Phoenix ICON wide-field infant fundus image · 1240 x 1240 pixels · captured with the Phoenix ICON (100° field of view) — 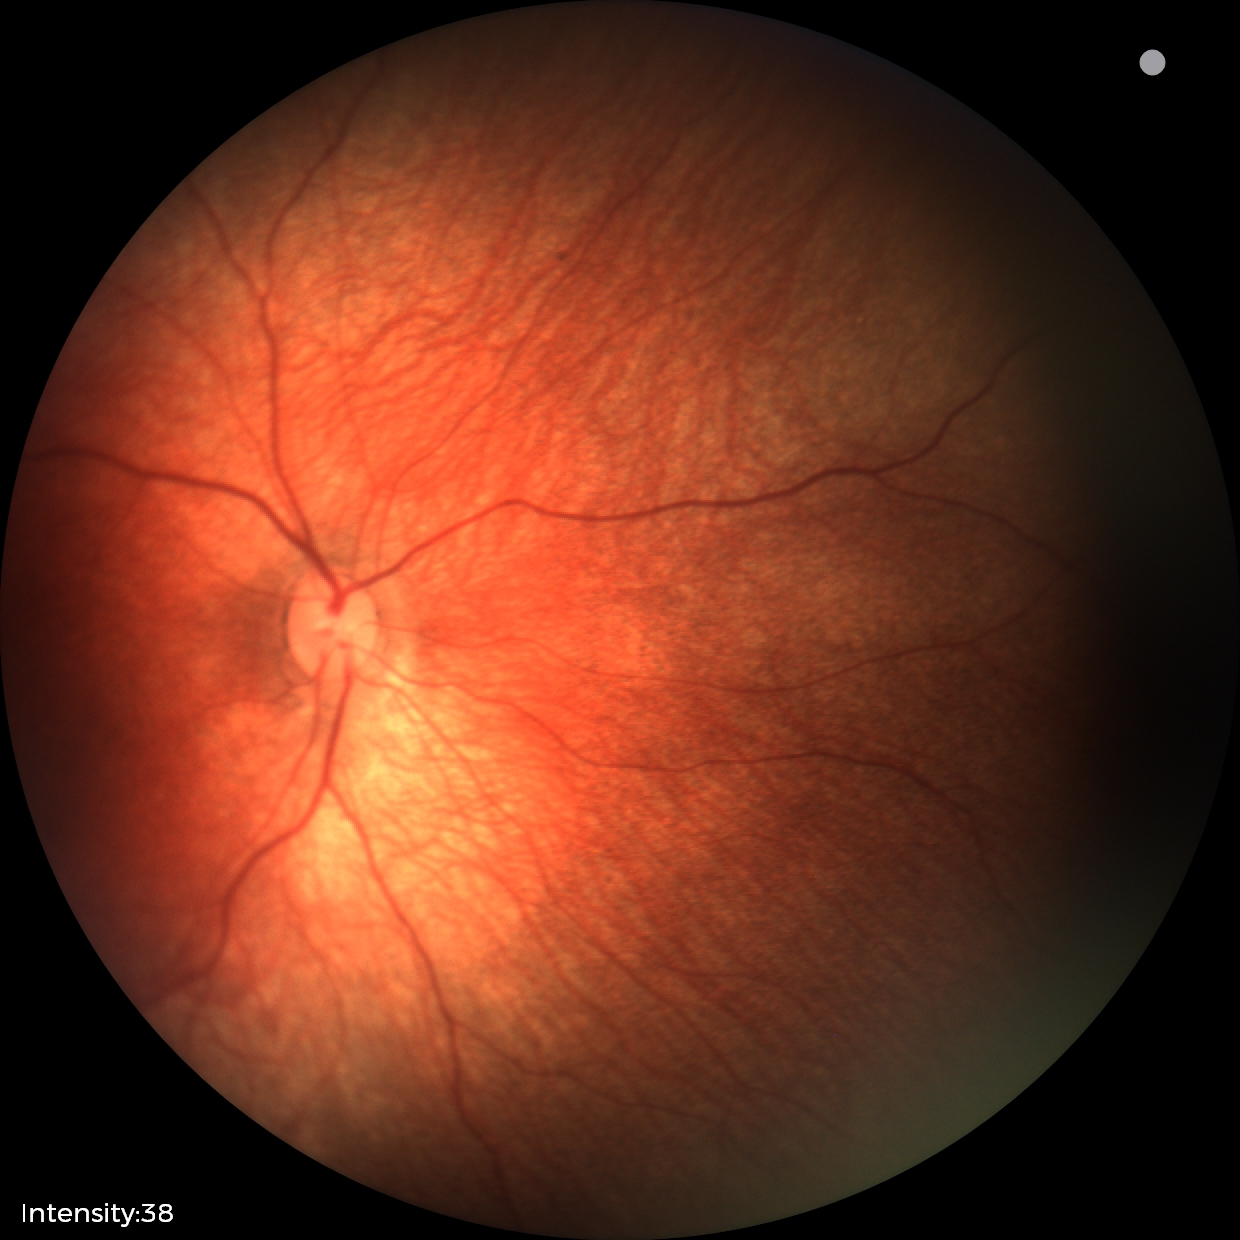
Screening series with retinal hemorrhages.